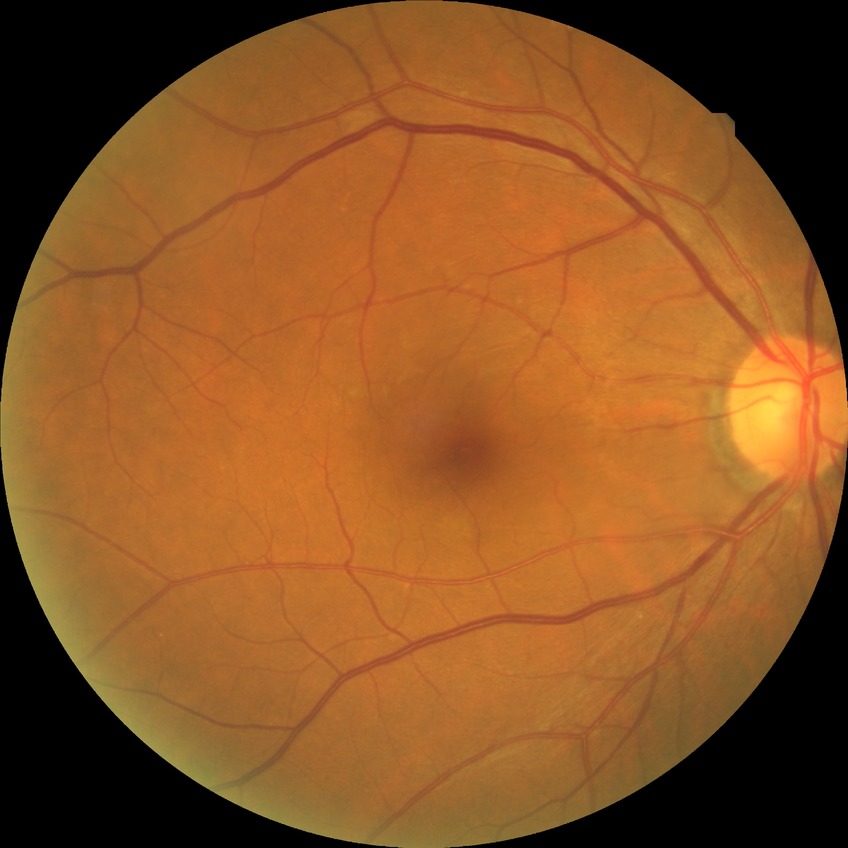
DR grade = NDR.